Davis DR grading:
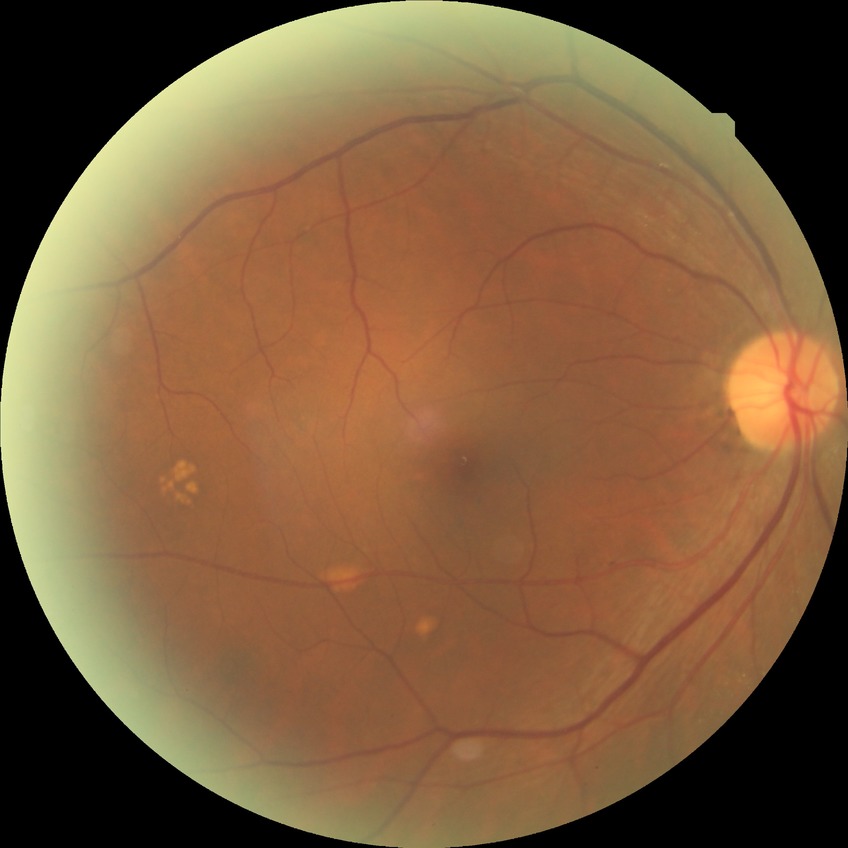
Annotations:
– diabetic retinopathy (DR): simple diabetic retinopathy (SDR)